45° field of view: 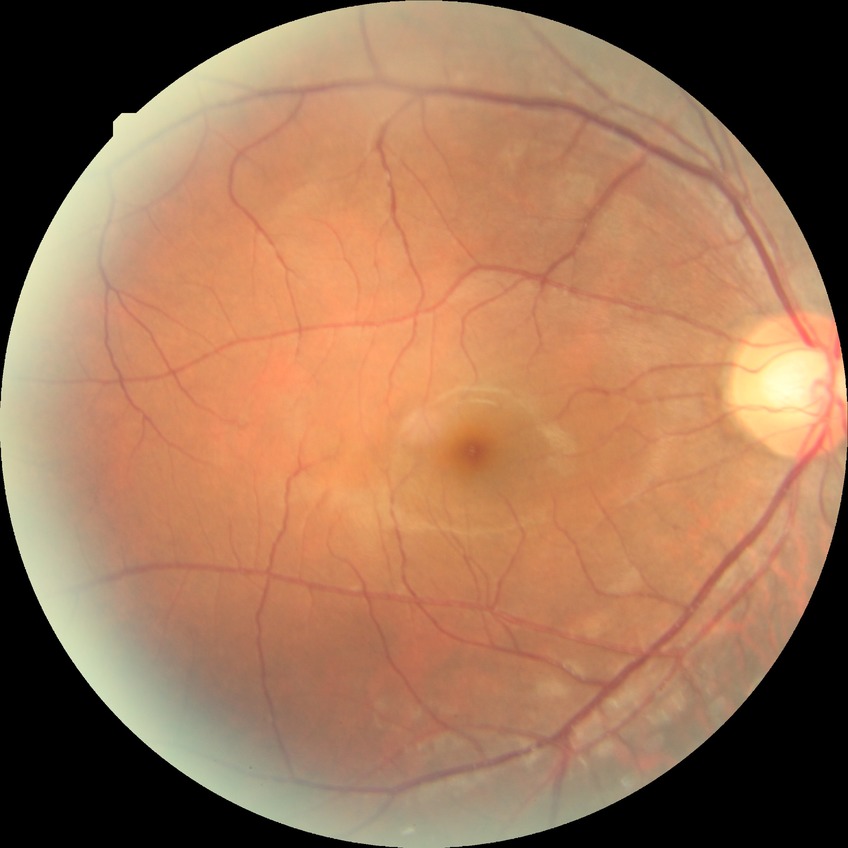
DR grade: NDR. No signs of diabetic retinopathy.